45° field of view — 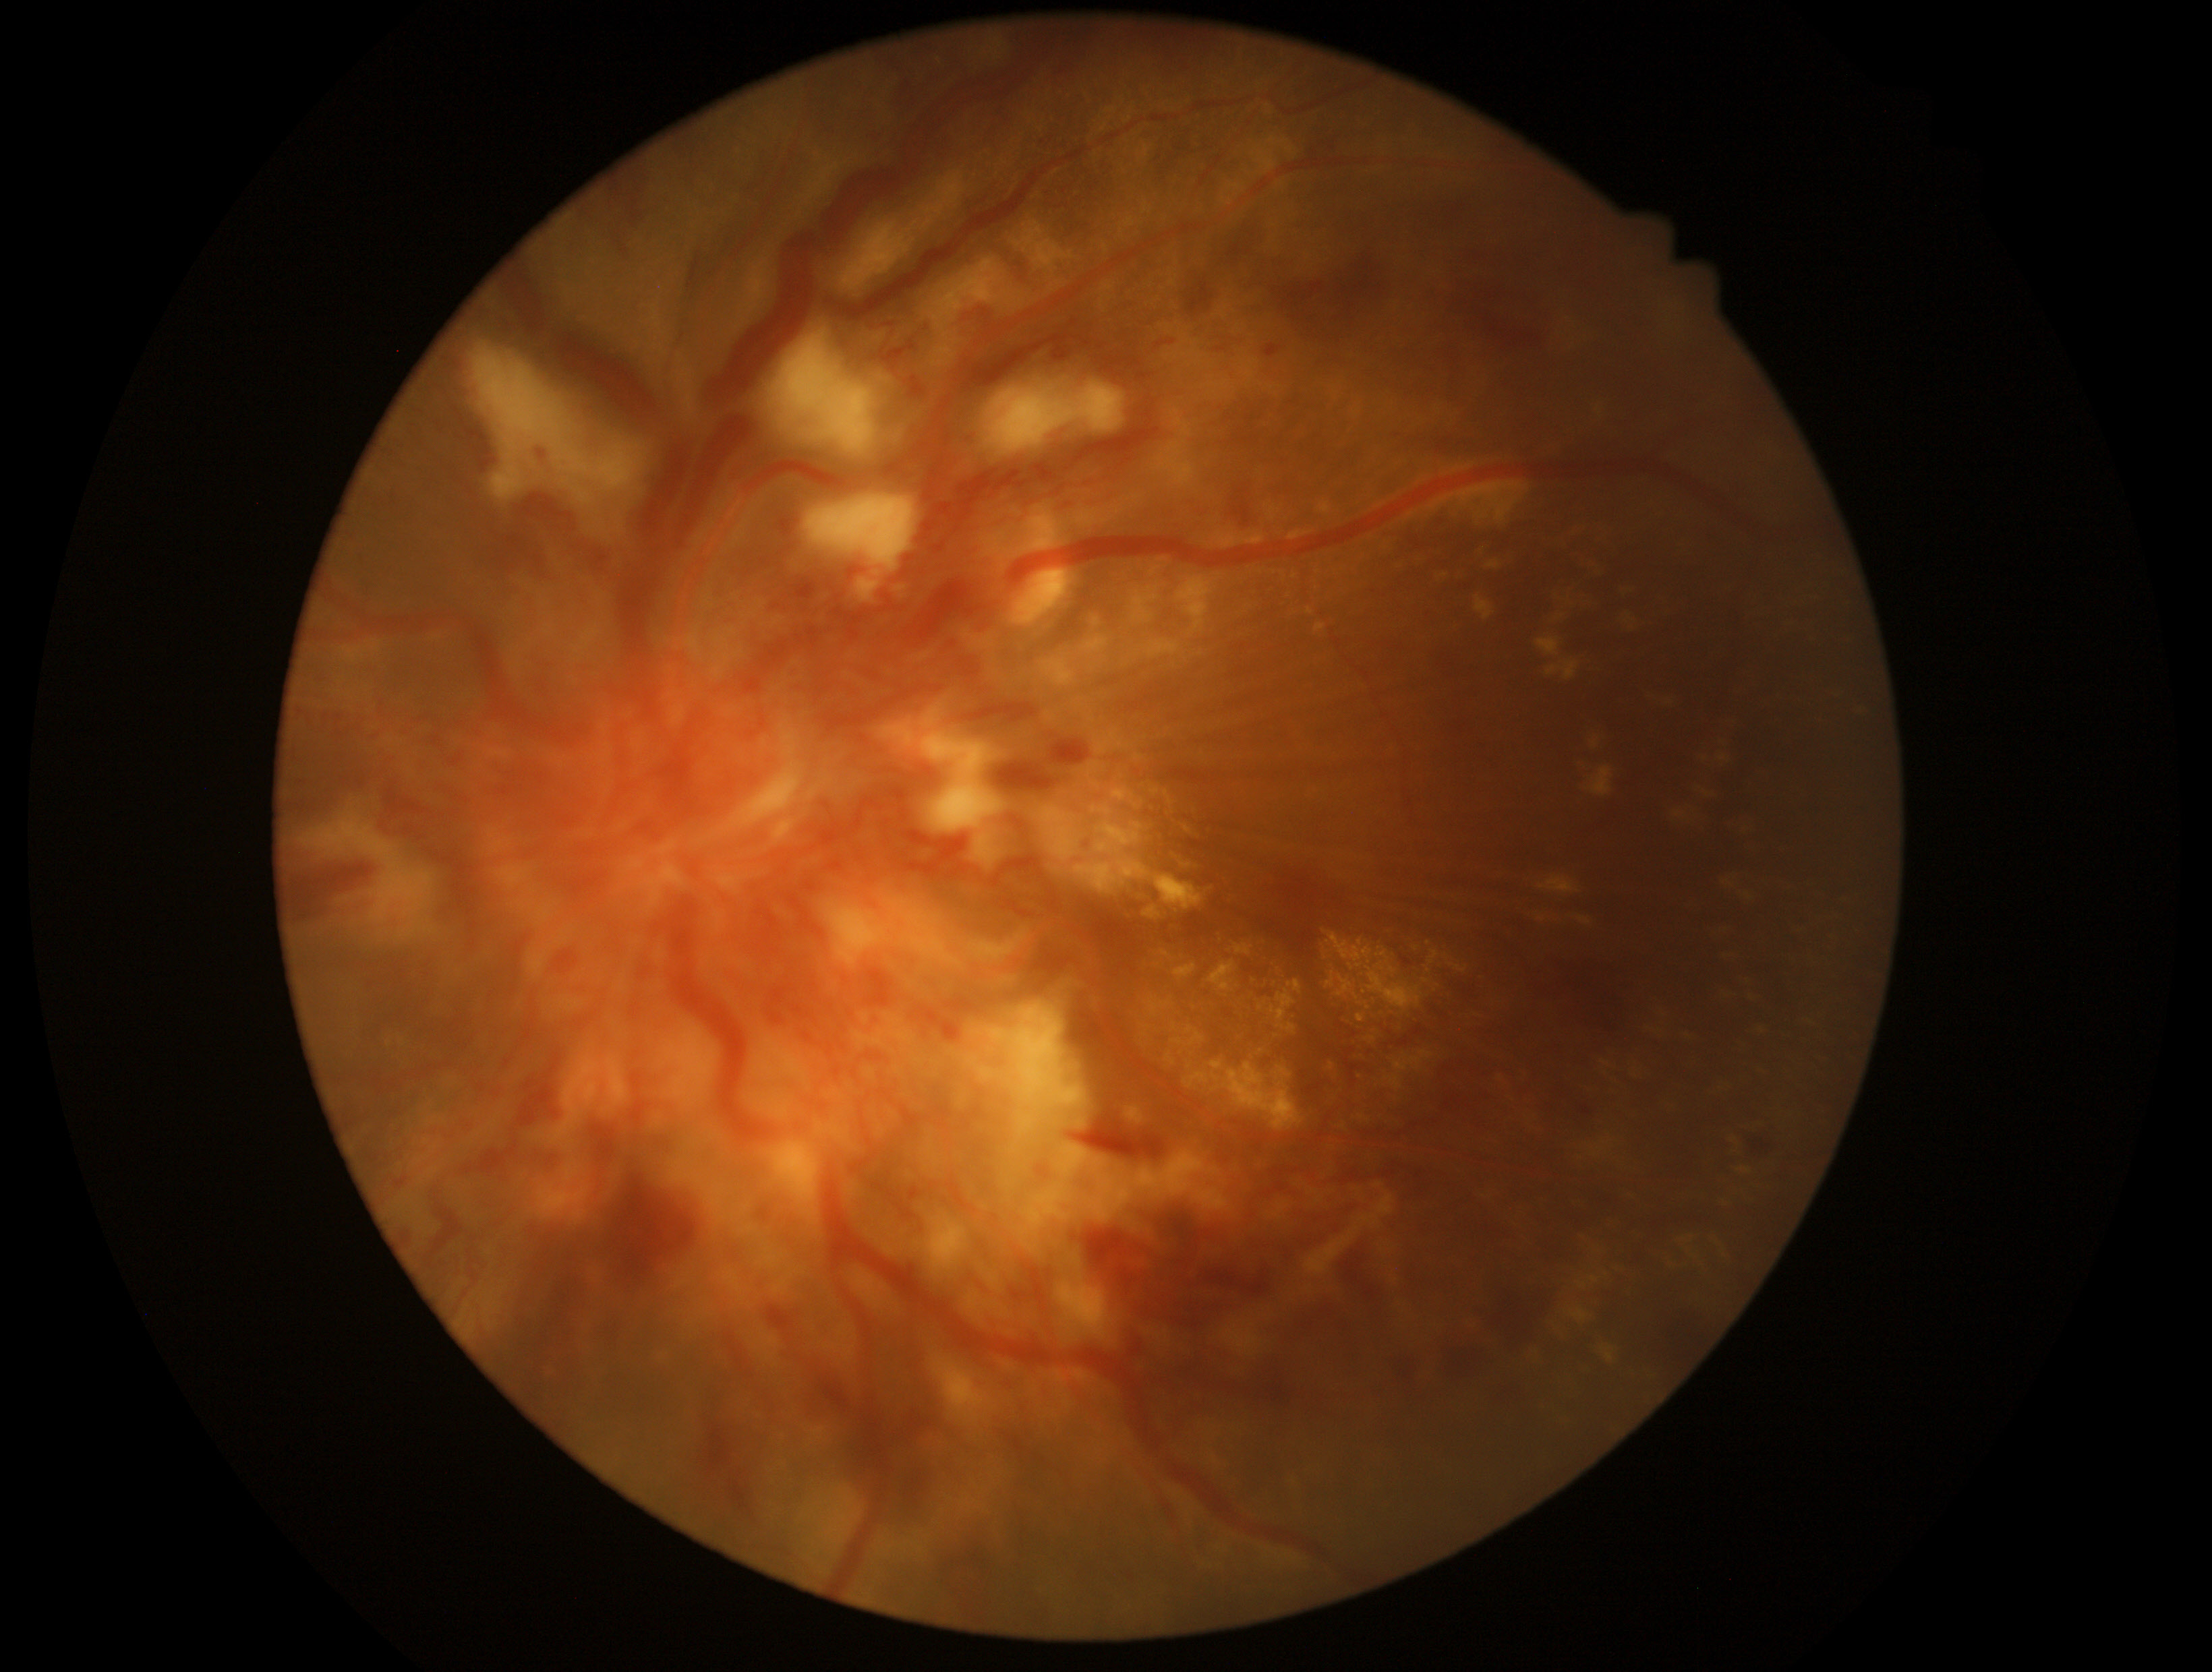

retinopathy grade=4.